Color fundus image; woman patient; 2212x1661px; patient age: 39 years; FOV: 30 degrees: 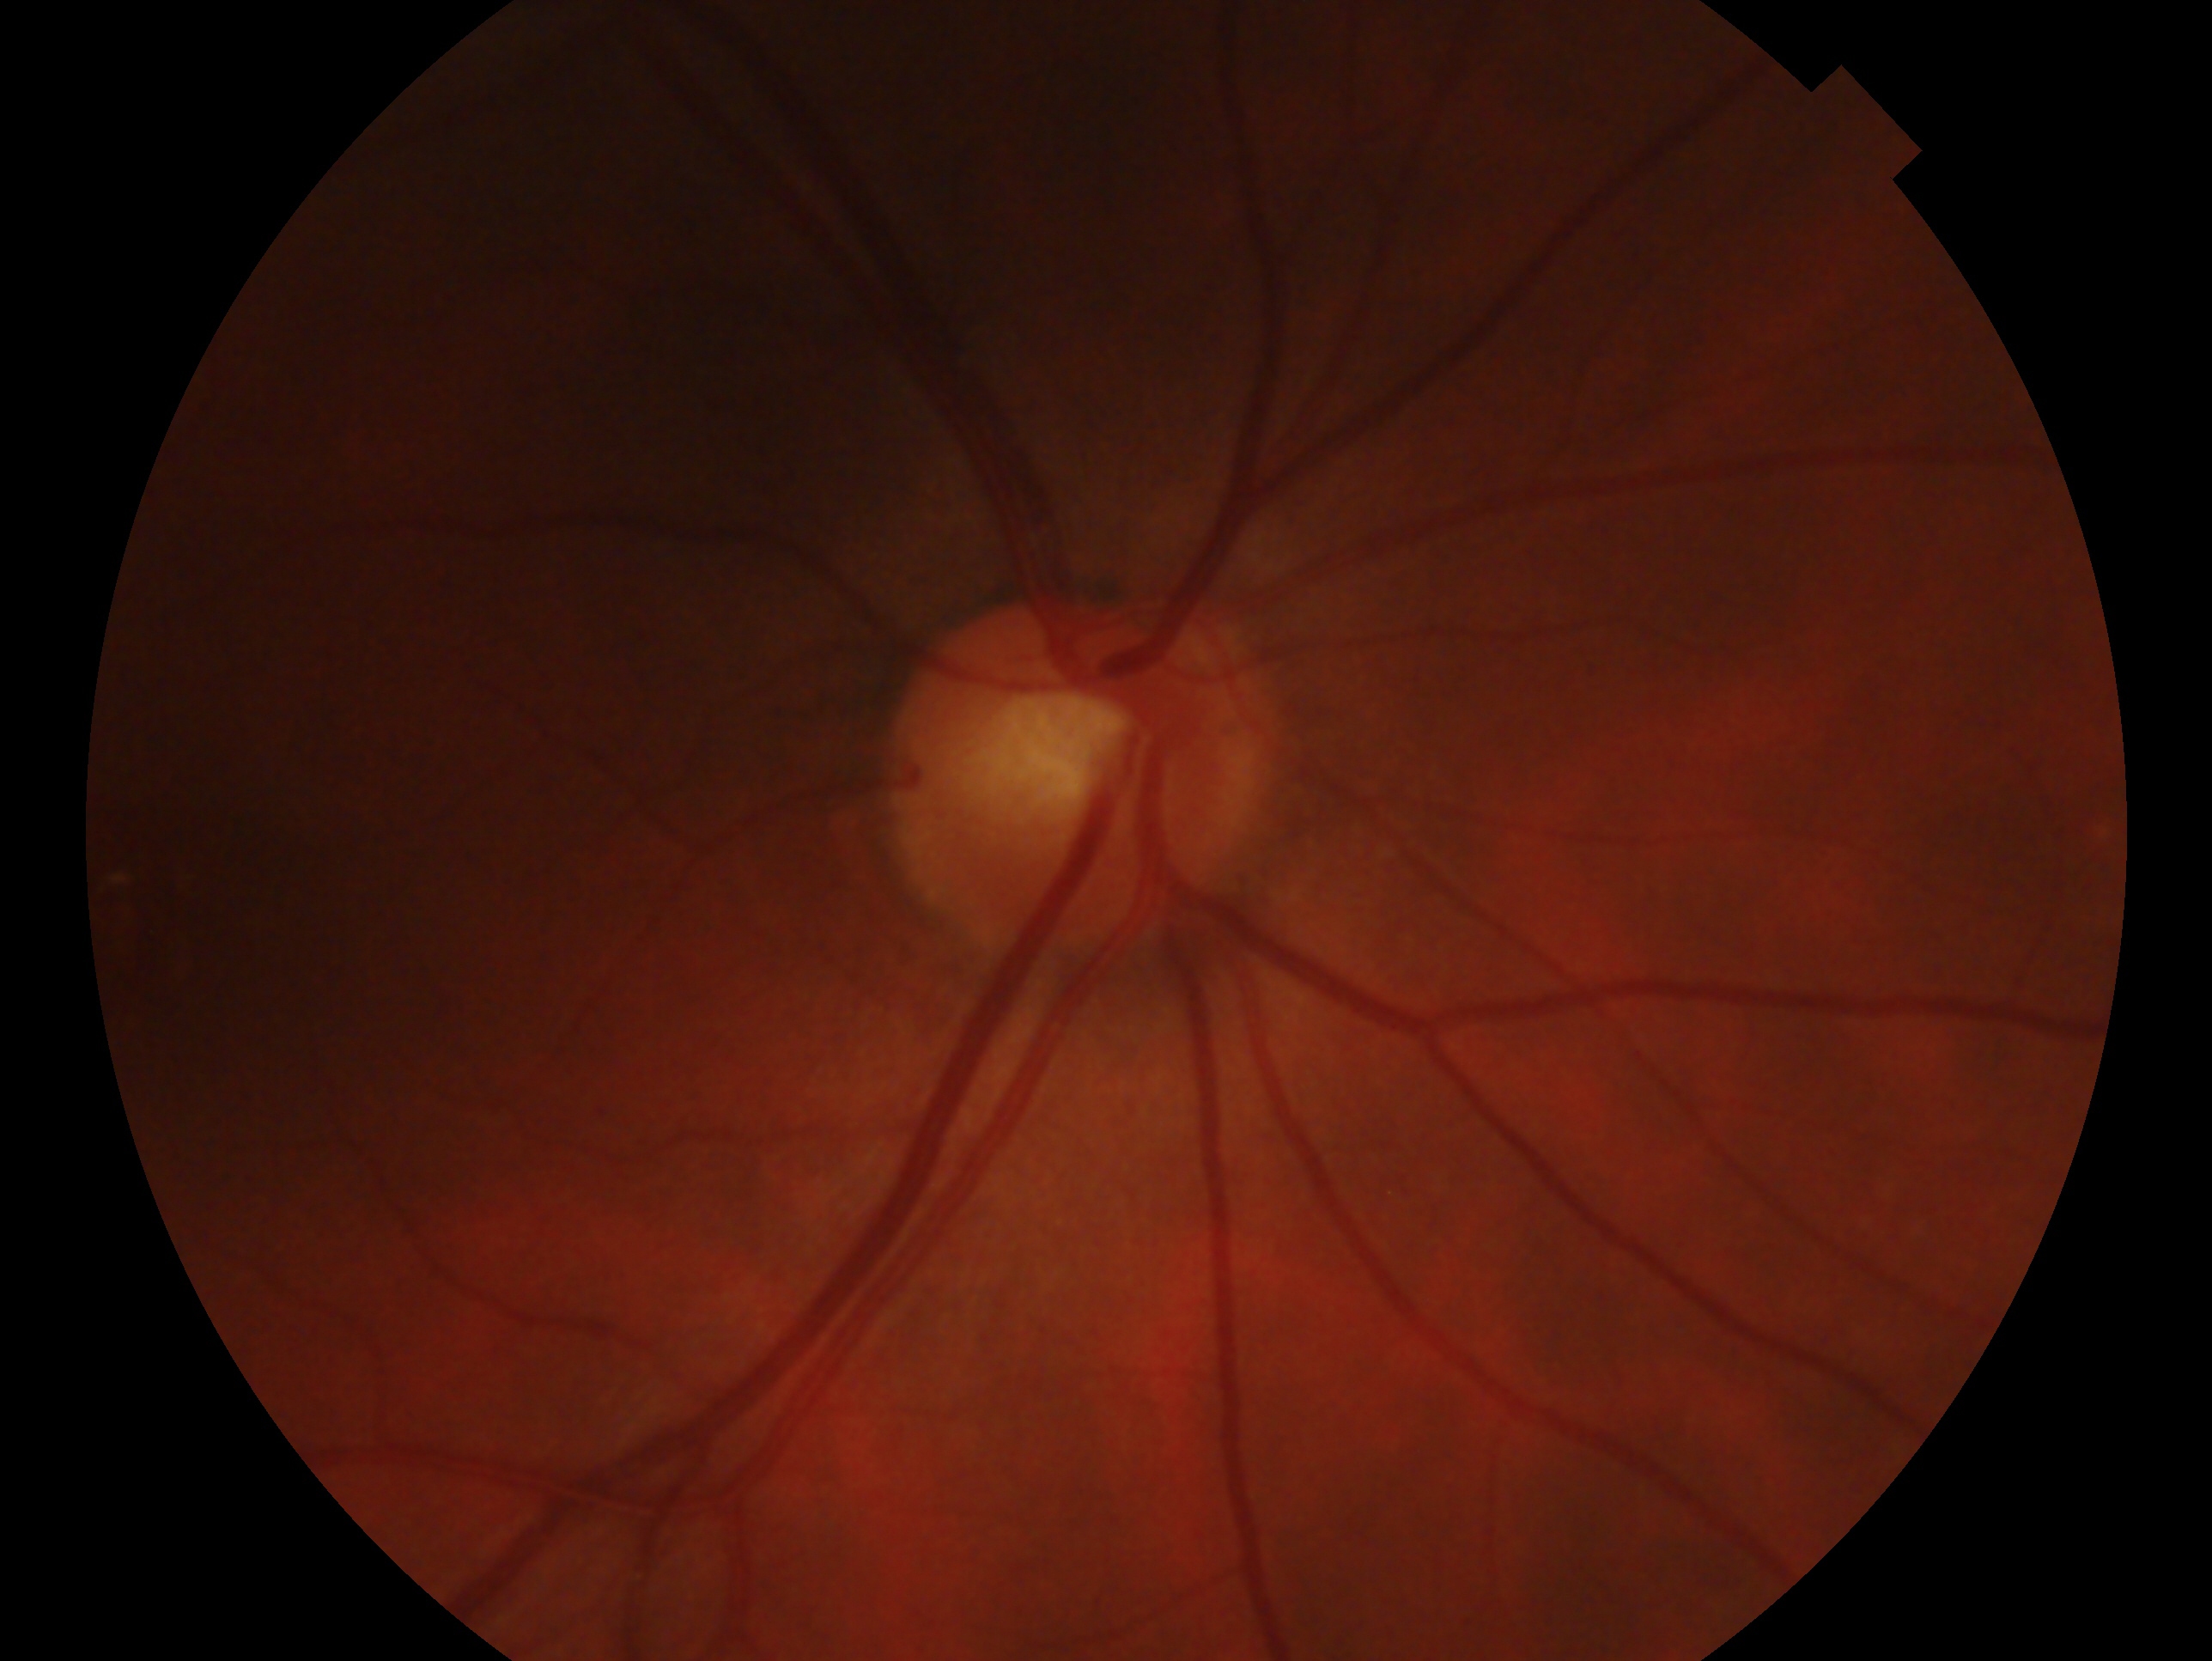
laterality=right
glaucoma diagnosis=no glaucoma — no clinical evidence of glaucoma in this eye